Retinal fundus photograph. 2352x1568:
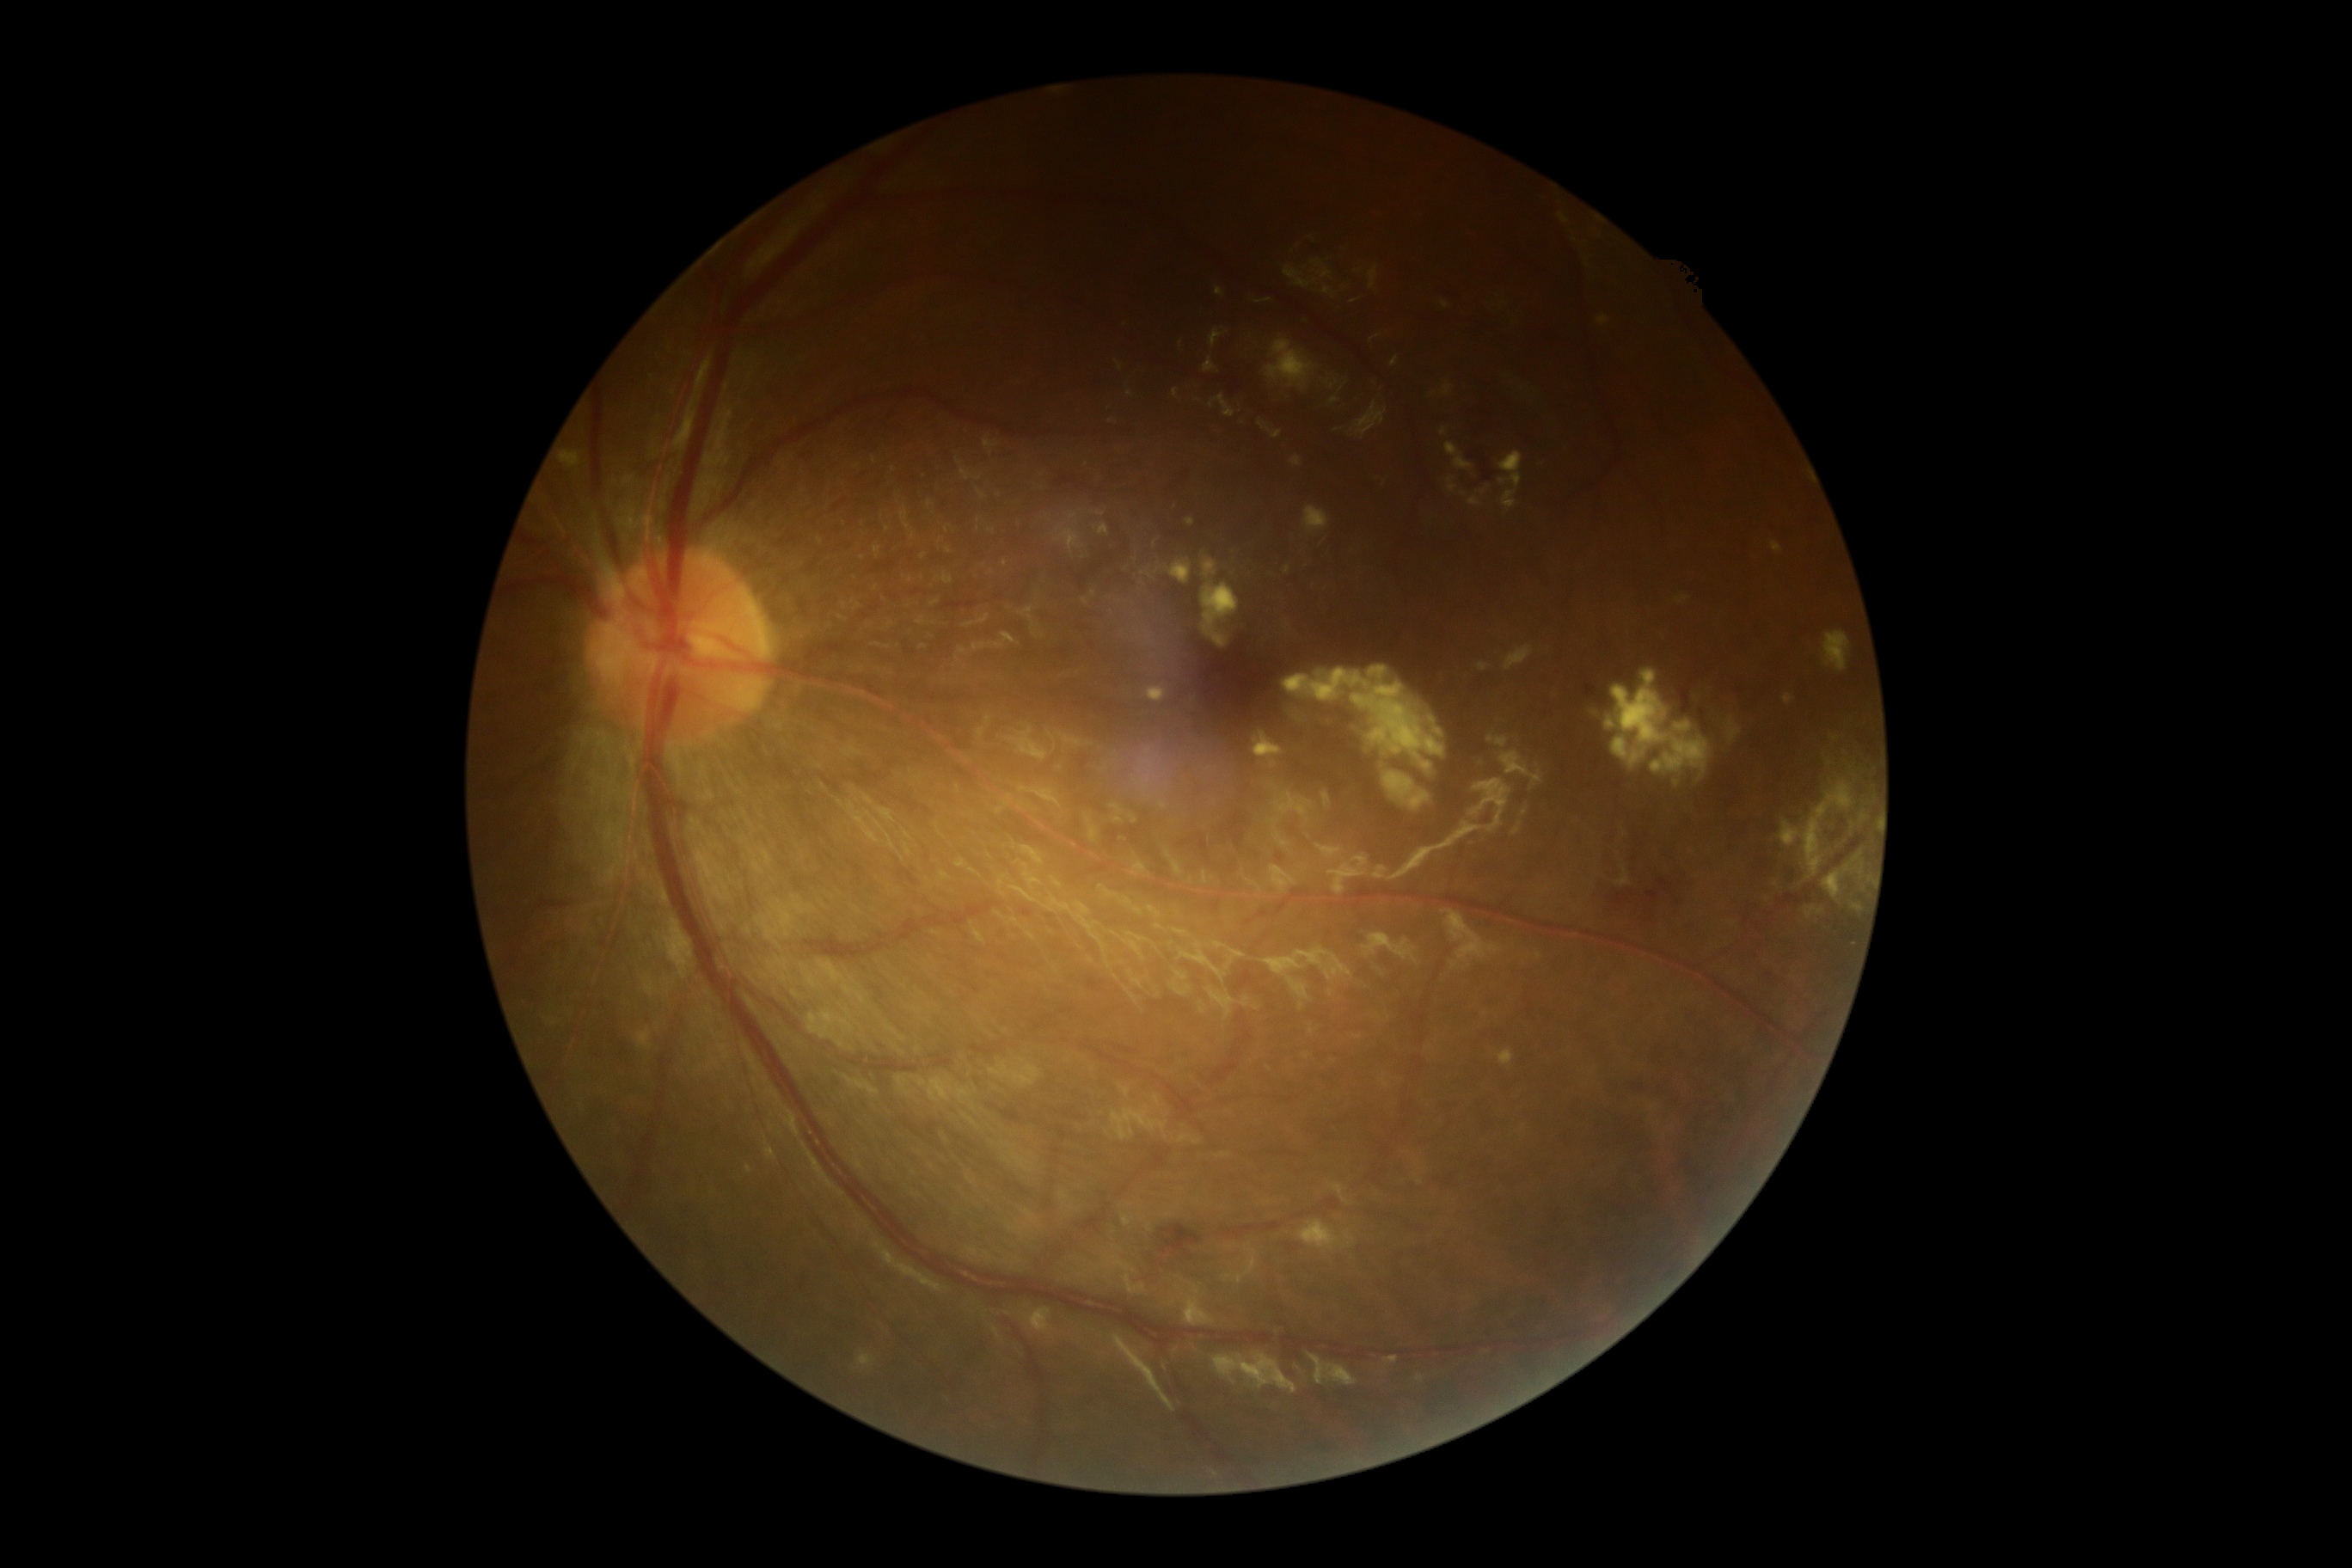 Diabetic retinopathy grade is moderate non-proliferative diabetic retinopathy (2).